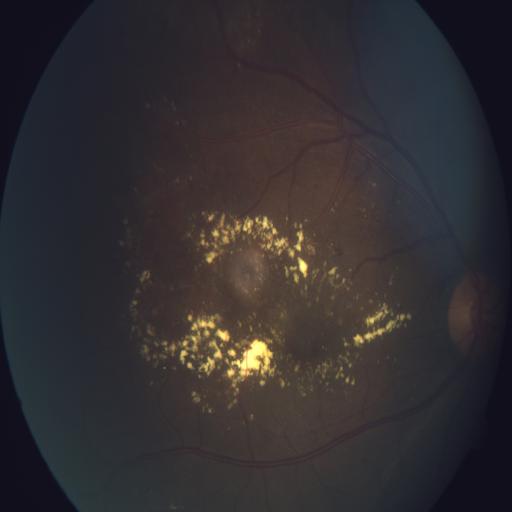

2 findings. Retinal fundus photograph demonstrating exudation and cystoid macular edema.